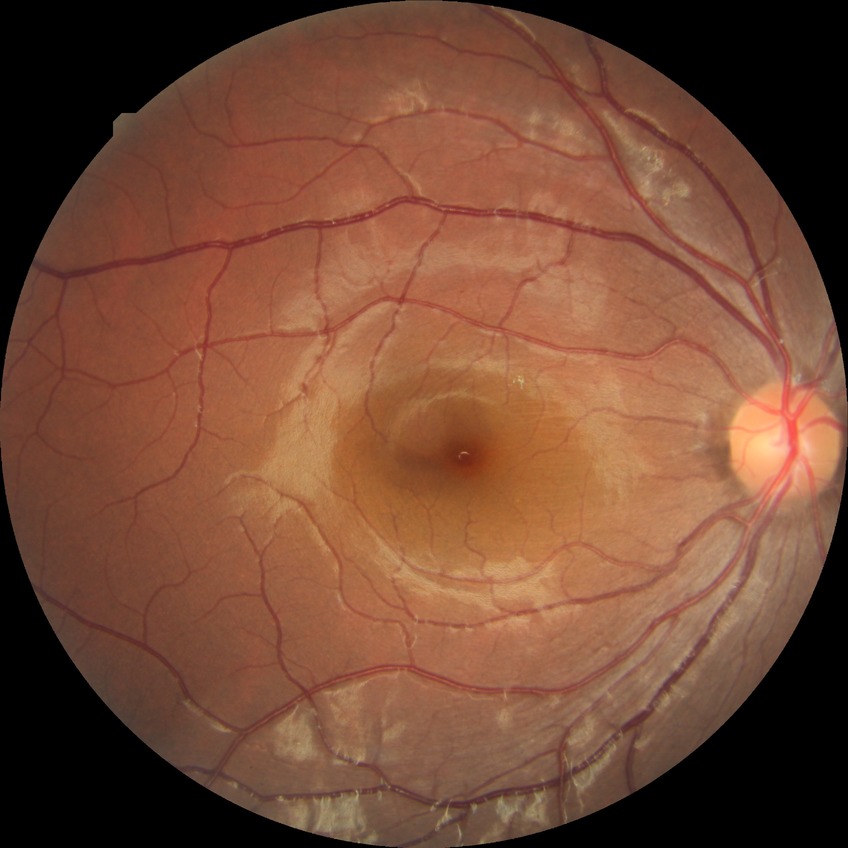
DR severity is SDR.